Retinal fundus photograph, 45° field of view, nonmydriatic:
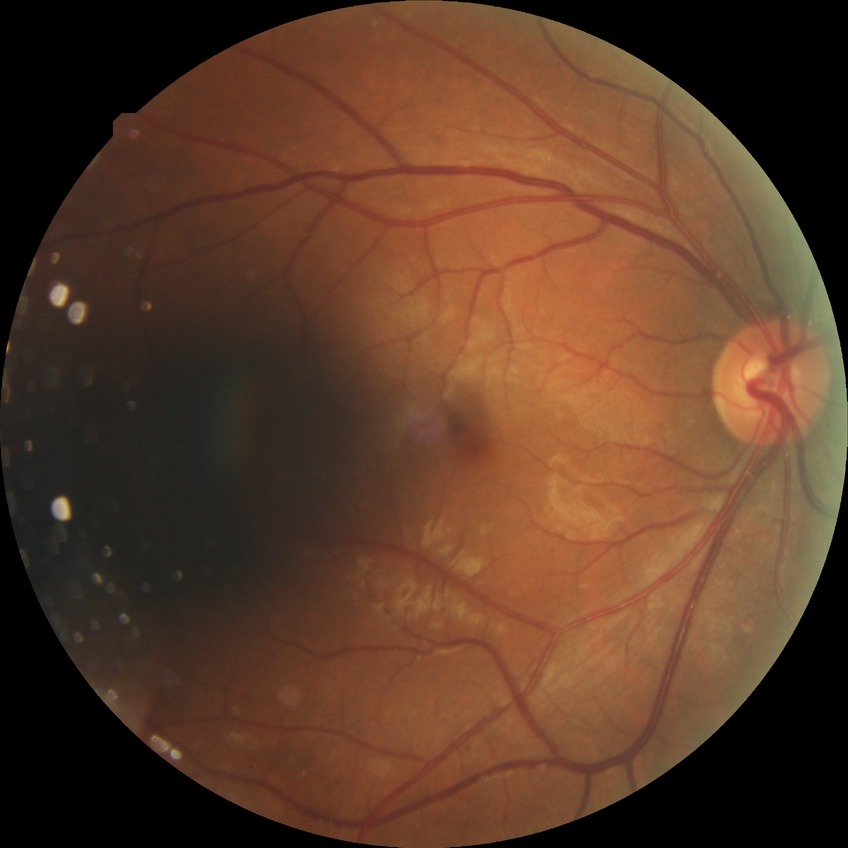
  davis_grade: simple diabetic retinopathy
  proliferative_class: non-proliferative diabetic retinopathy